Wide-field contact fundus photograph of an infant — 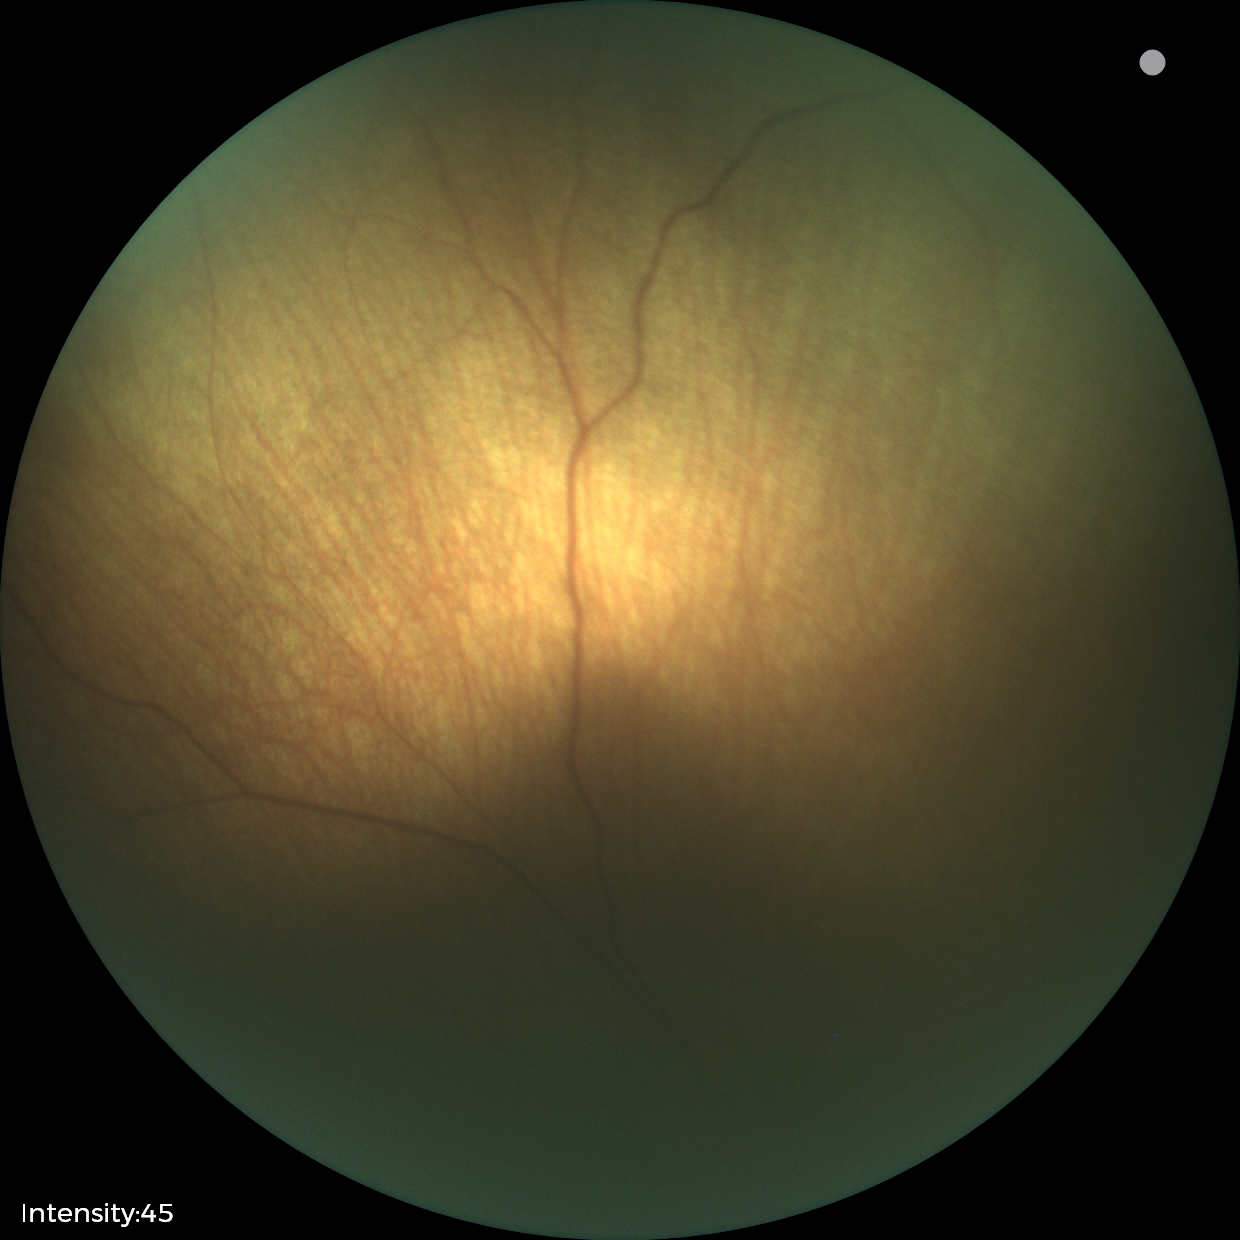
Screening examination with no abnormal retinal findings.